Infant wide-field fundus photograph.
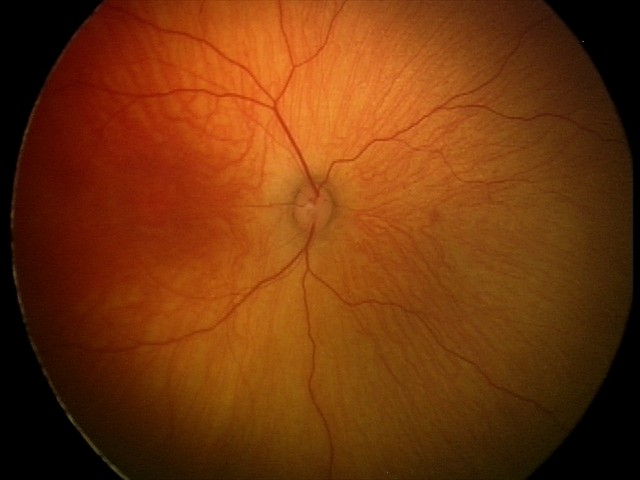
Examination with physiological retinal findings.